Wide-field fundus photograph from neonatal ROP screening. 1440 x 1080 pixels. 130° field of view (Natus RetCam Envision).
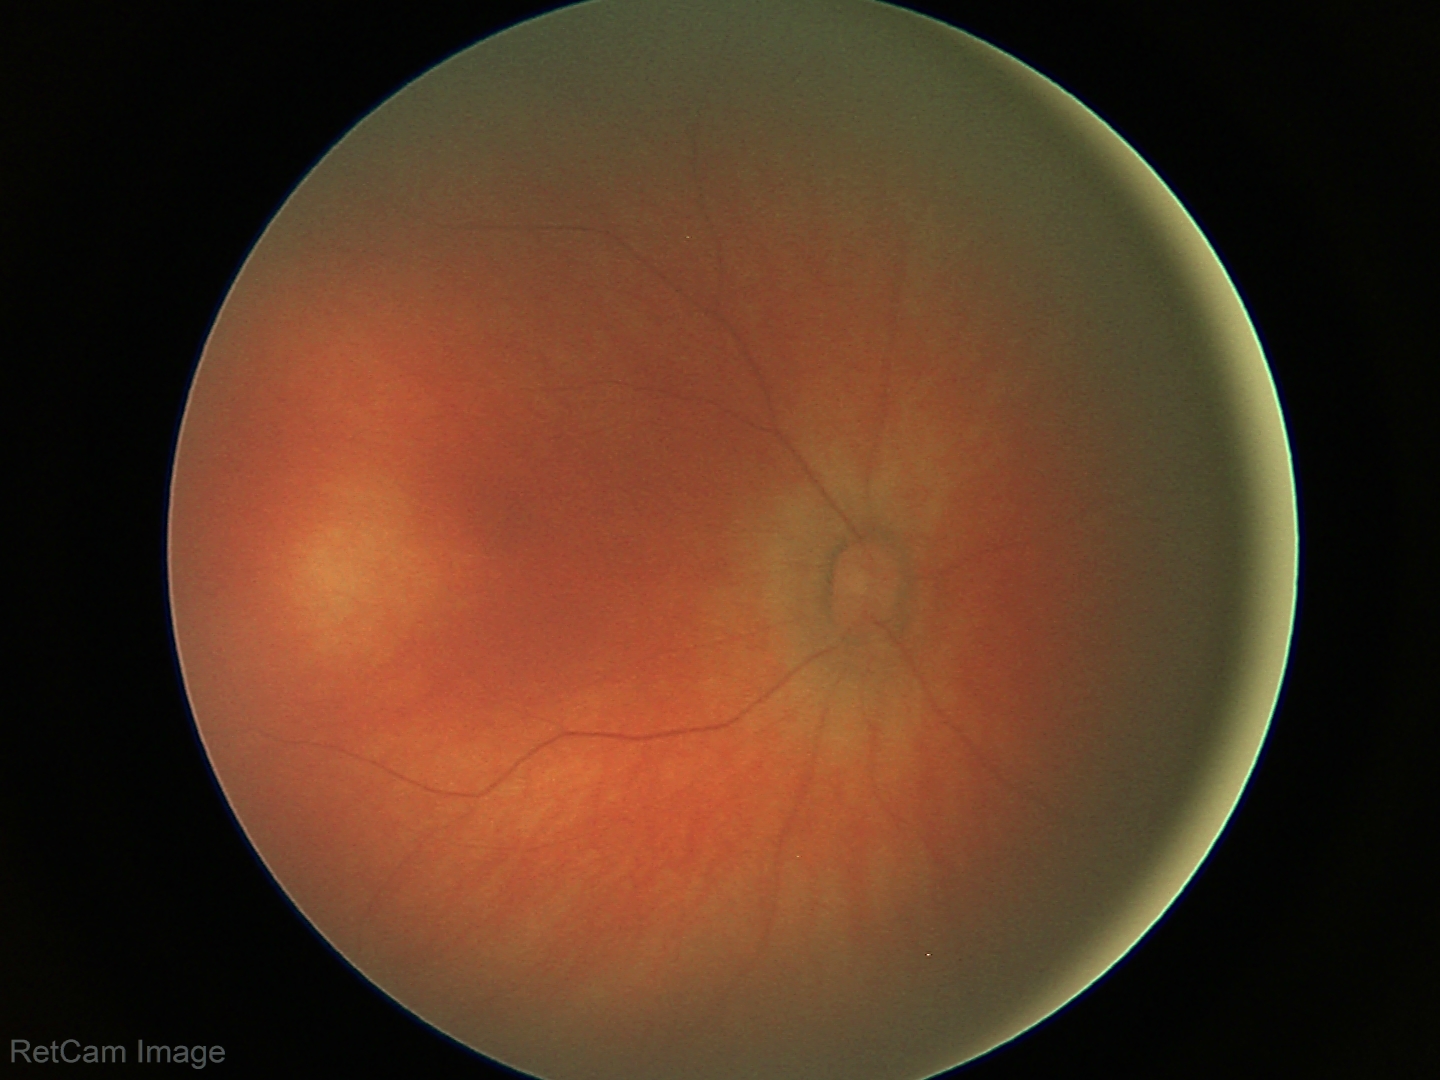 Screening diagnosis: physiological appearance with no retinal pathology.